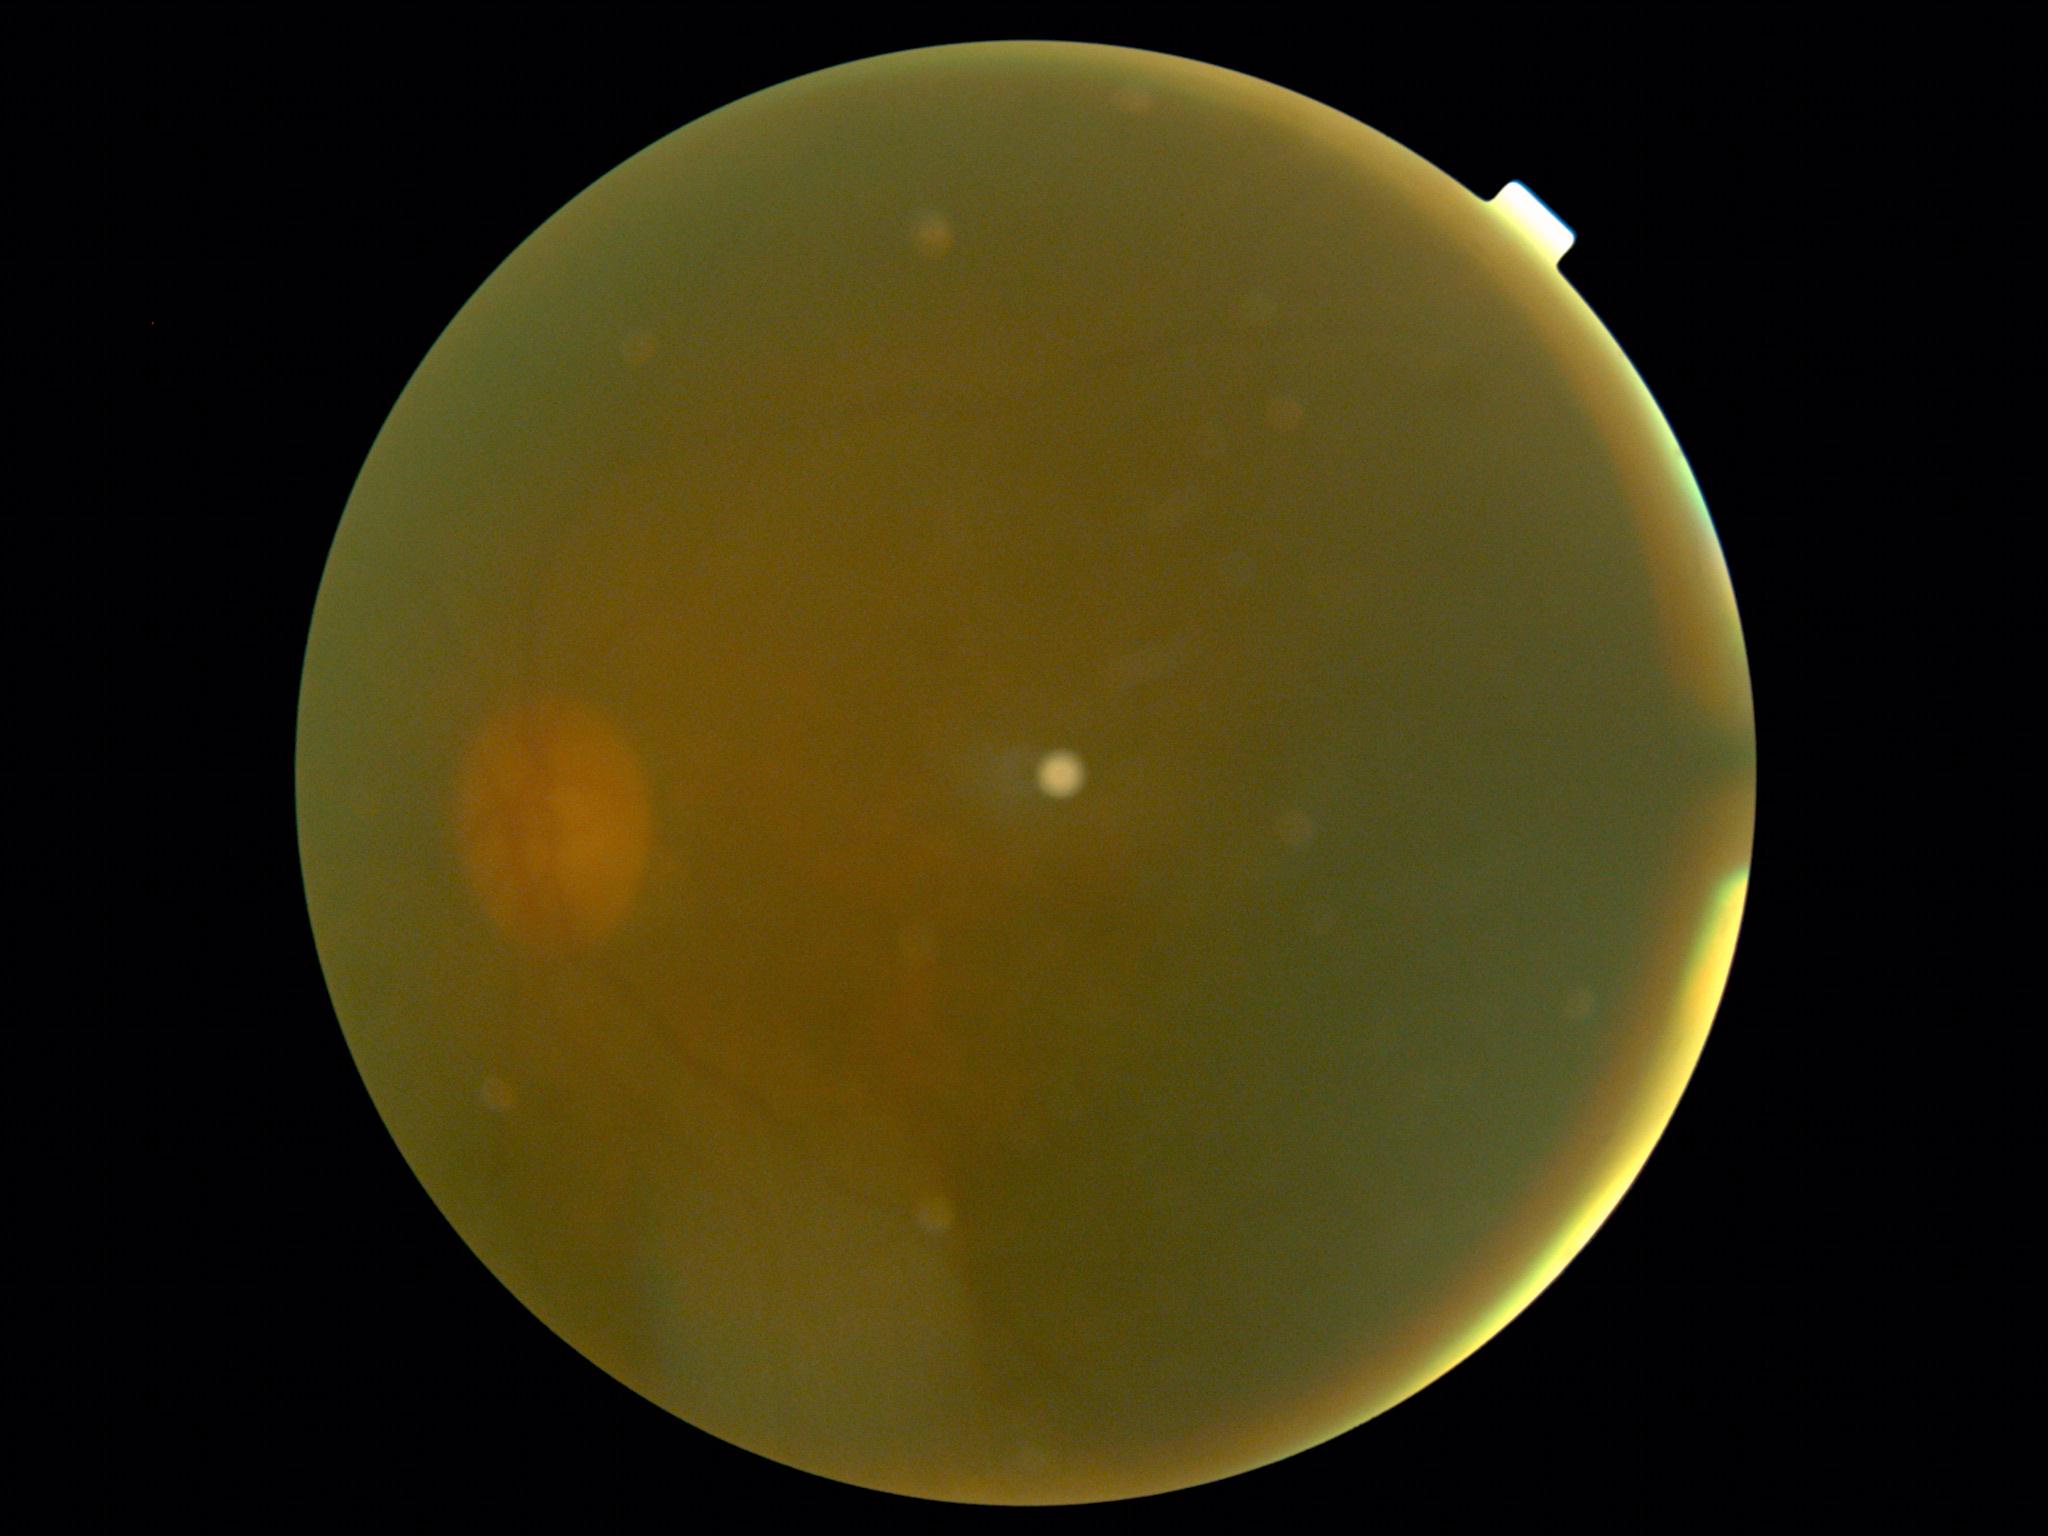 DR stage is ungradable. Quality too poor to assess for DR.